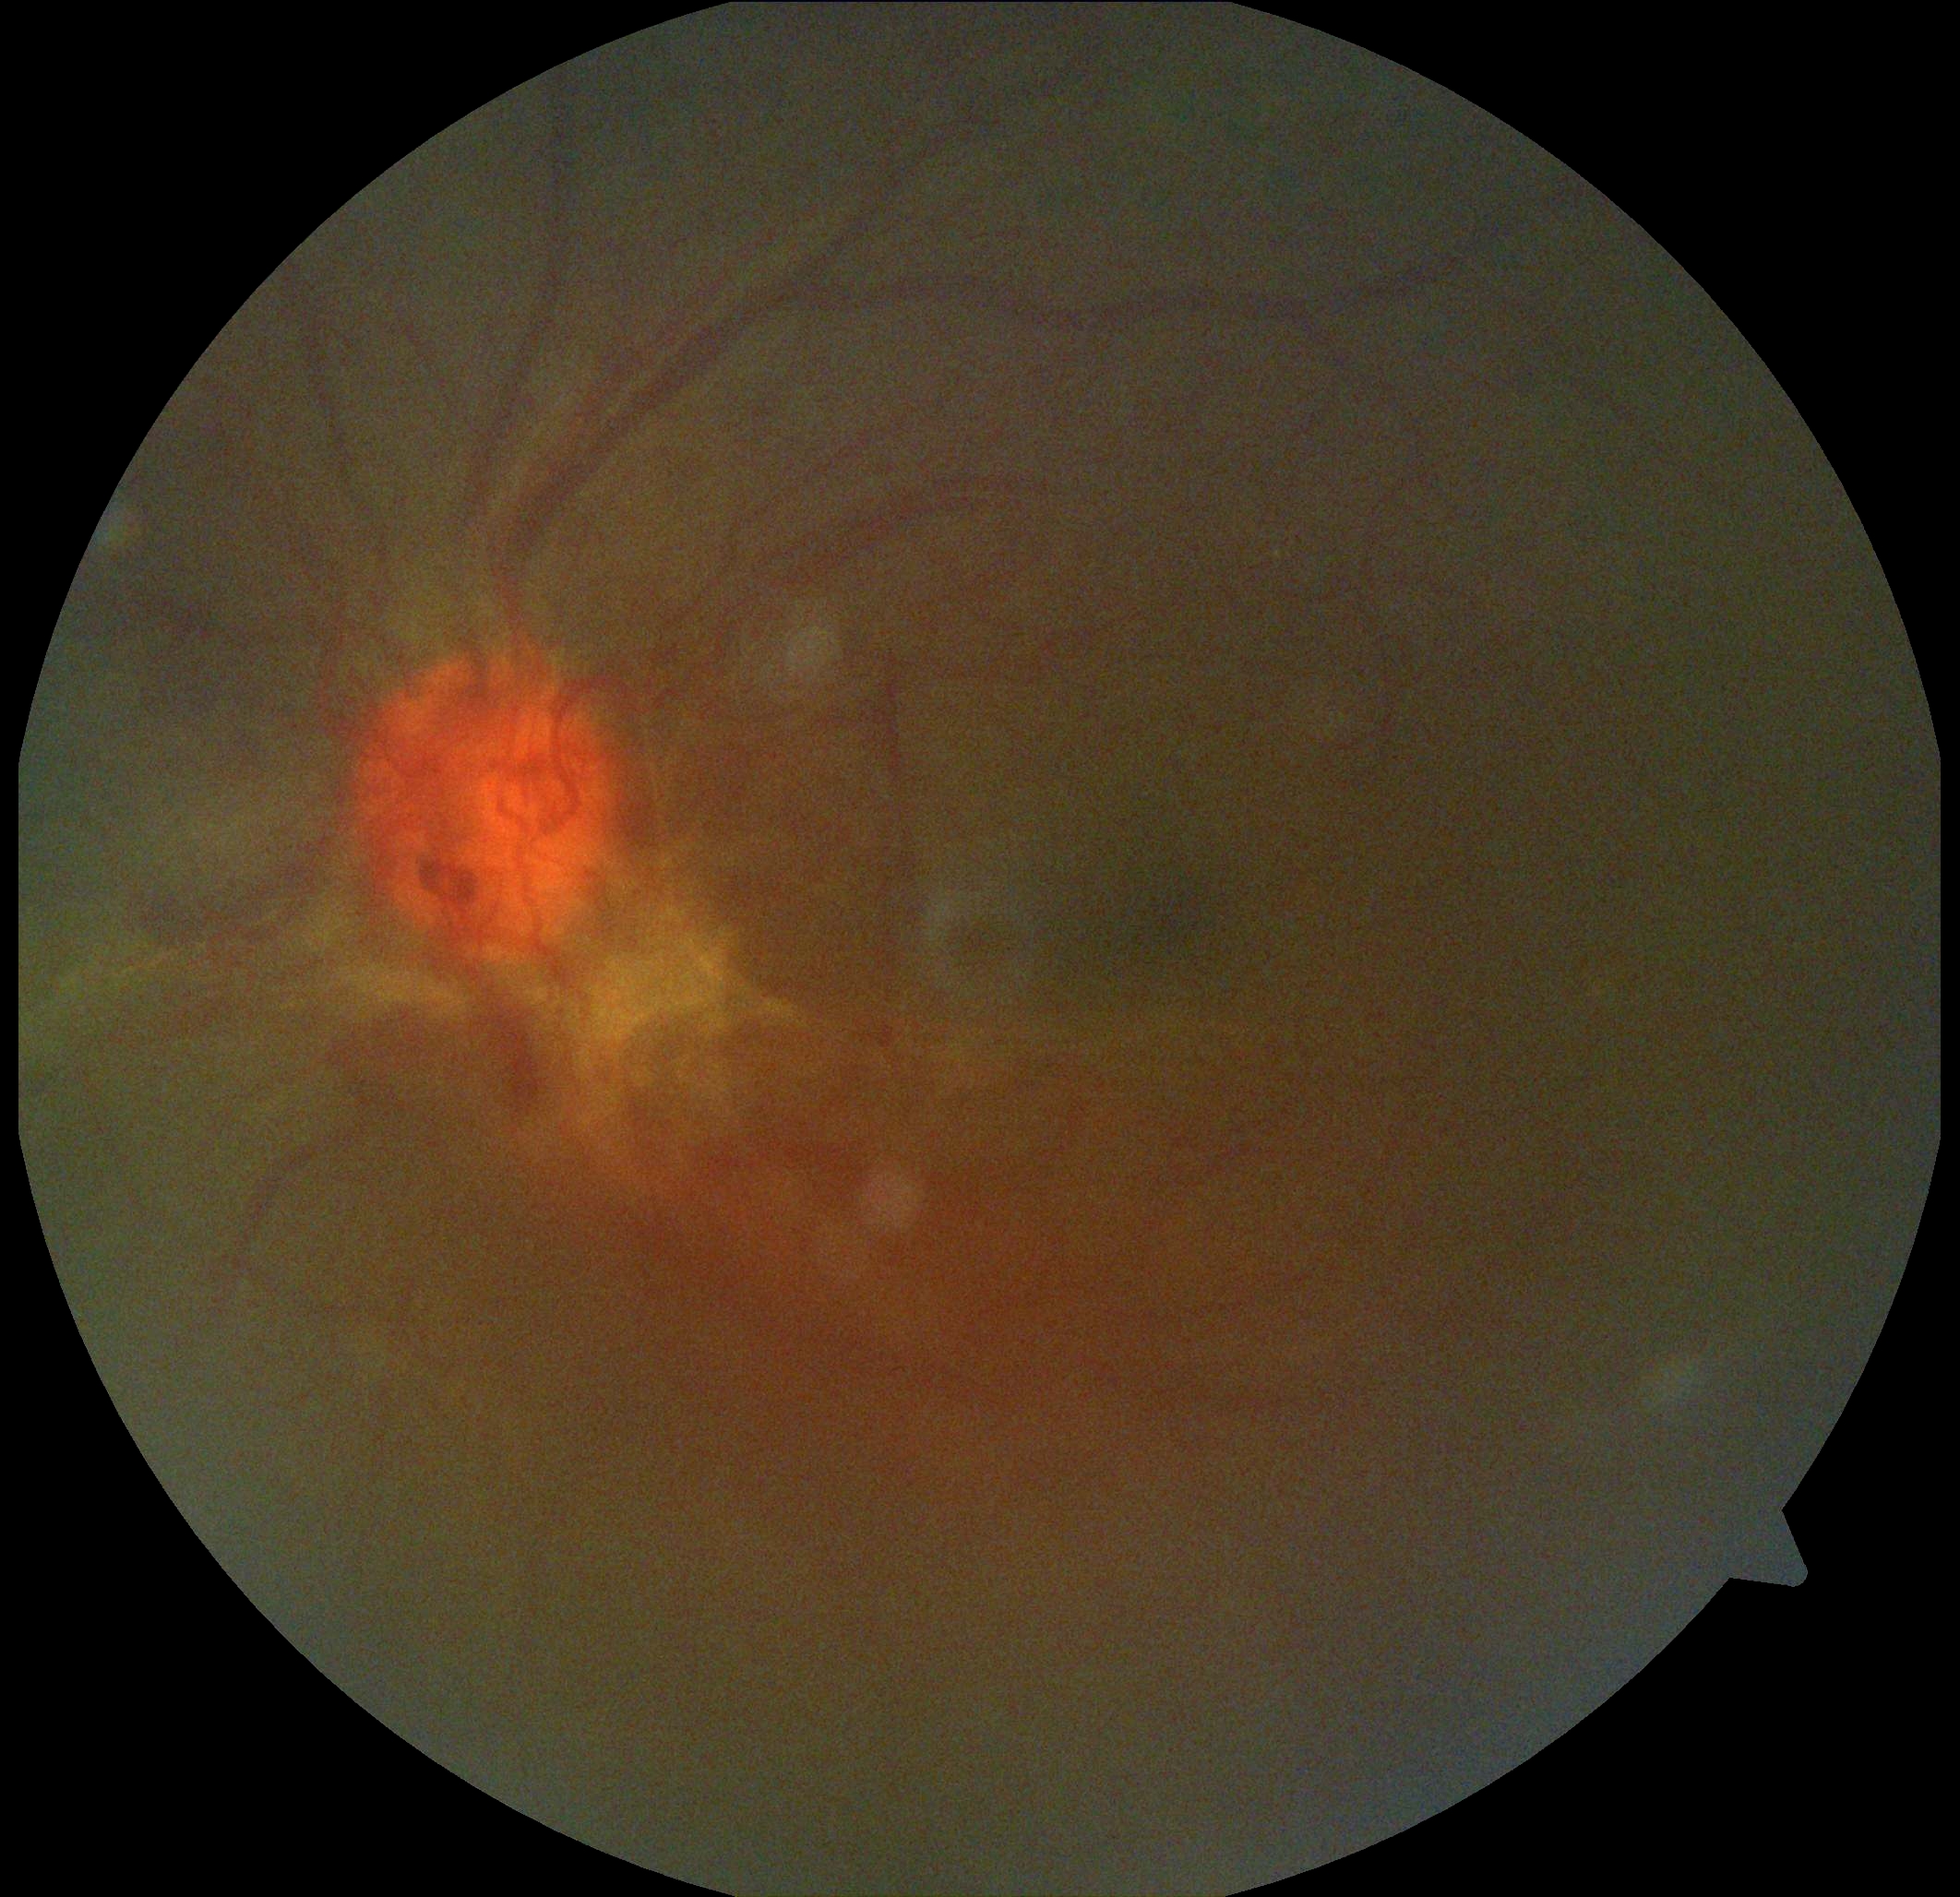 Diabetic retinopathy (DR): 4.